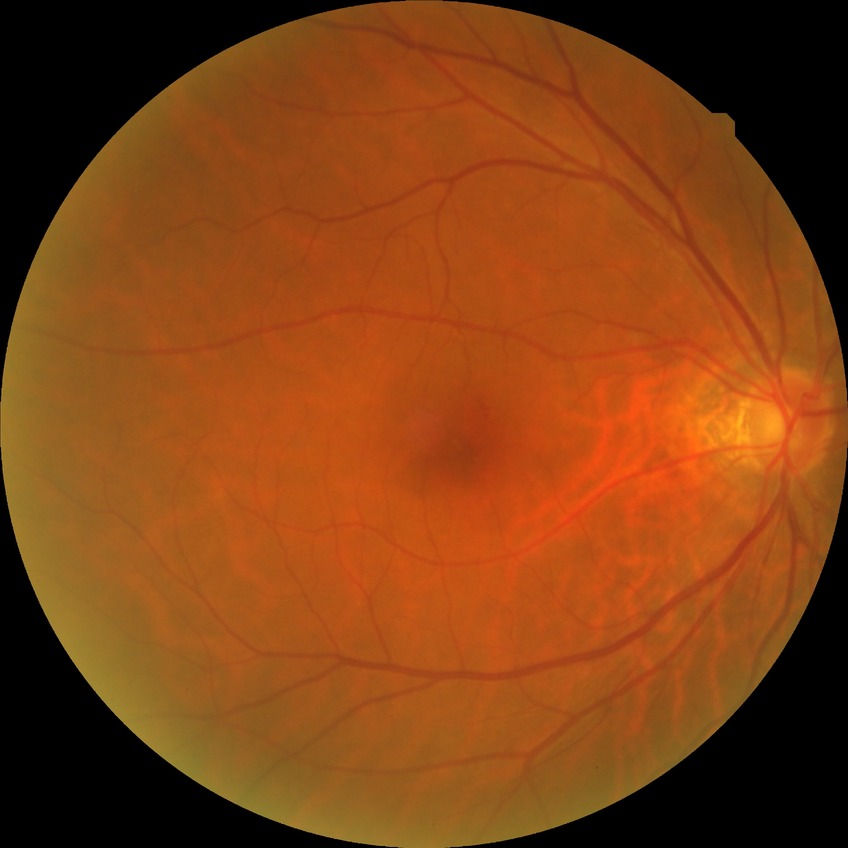
Retinopathy grade is simple diabetic retinopathy. Disease class: non-proliferative diabetic retinopathy.